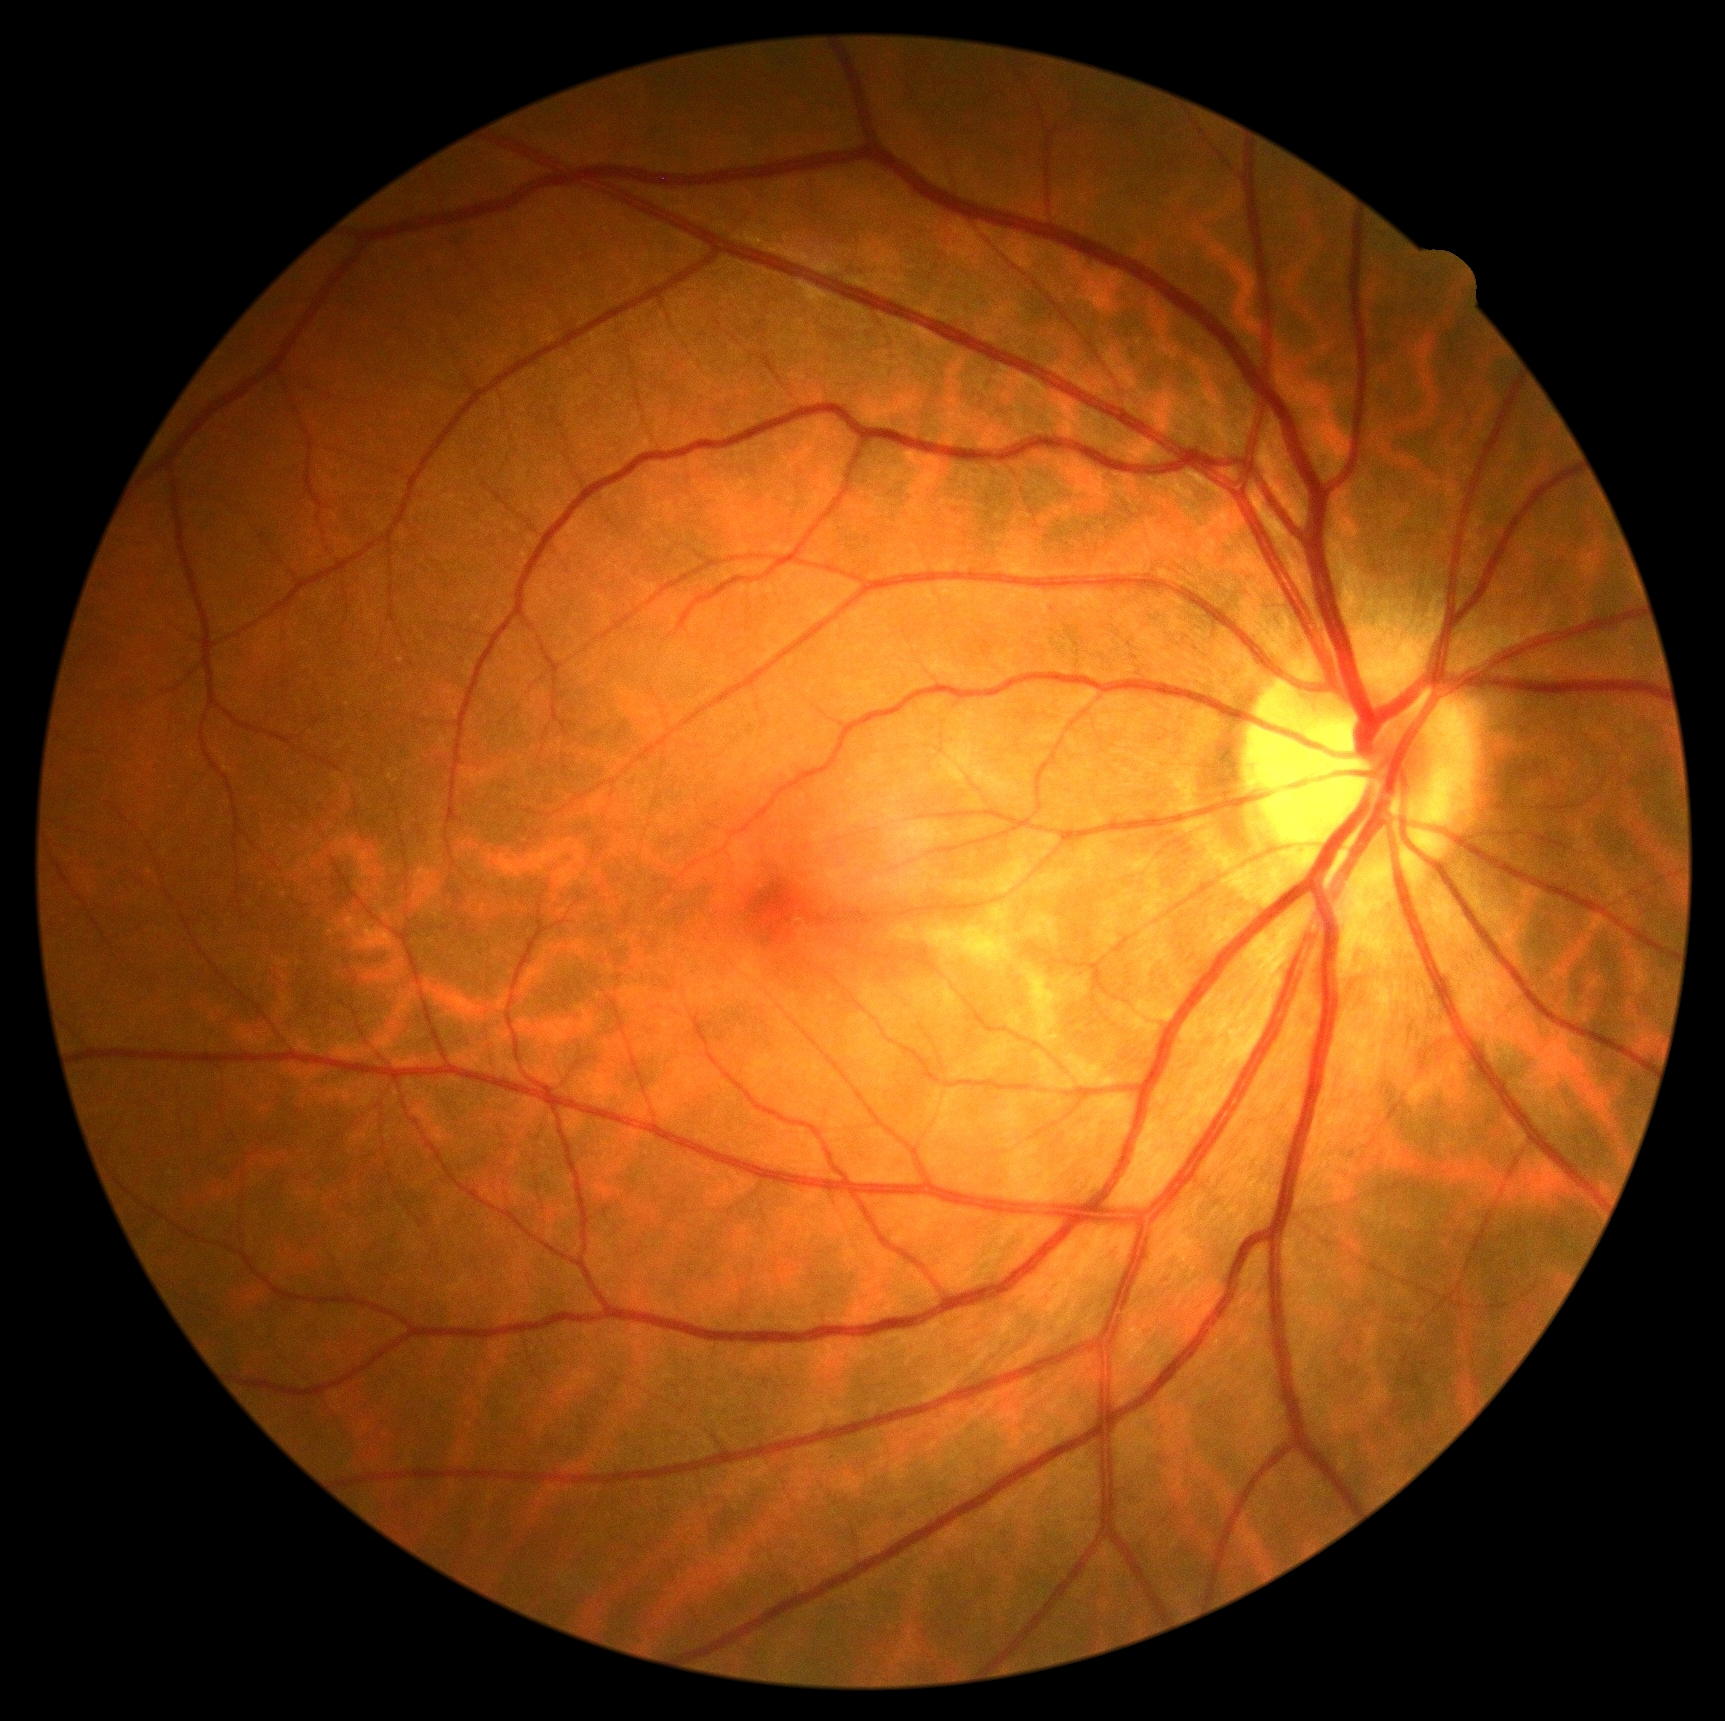

- DR impression: no signs of DR
- retinopathy grade: no apparent retinopathy (0)